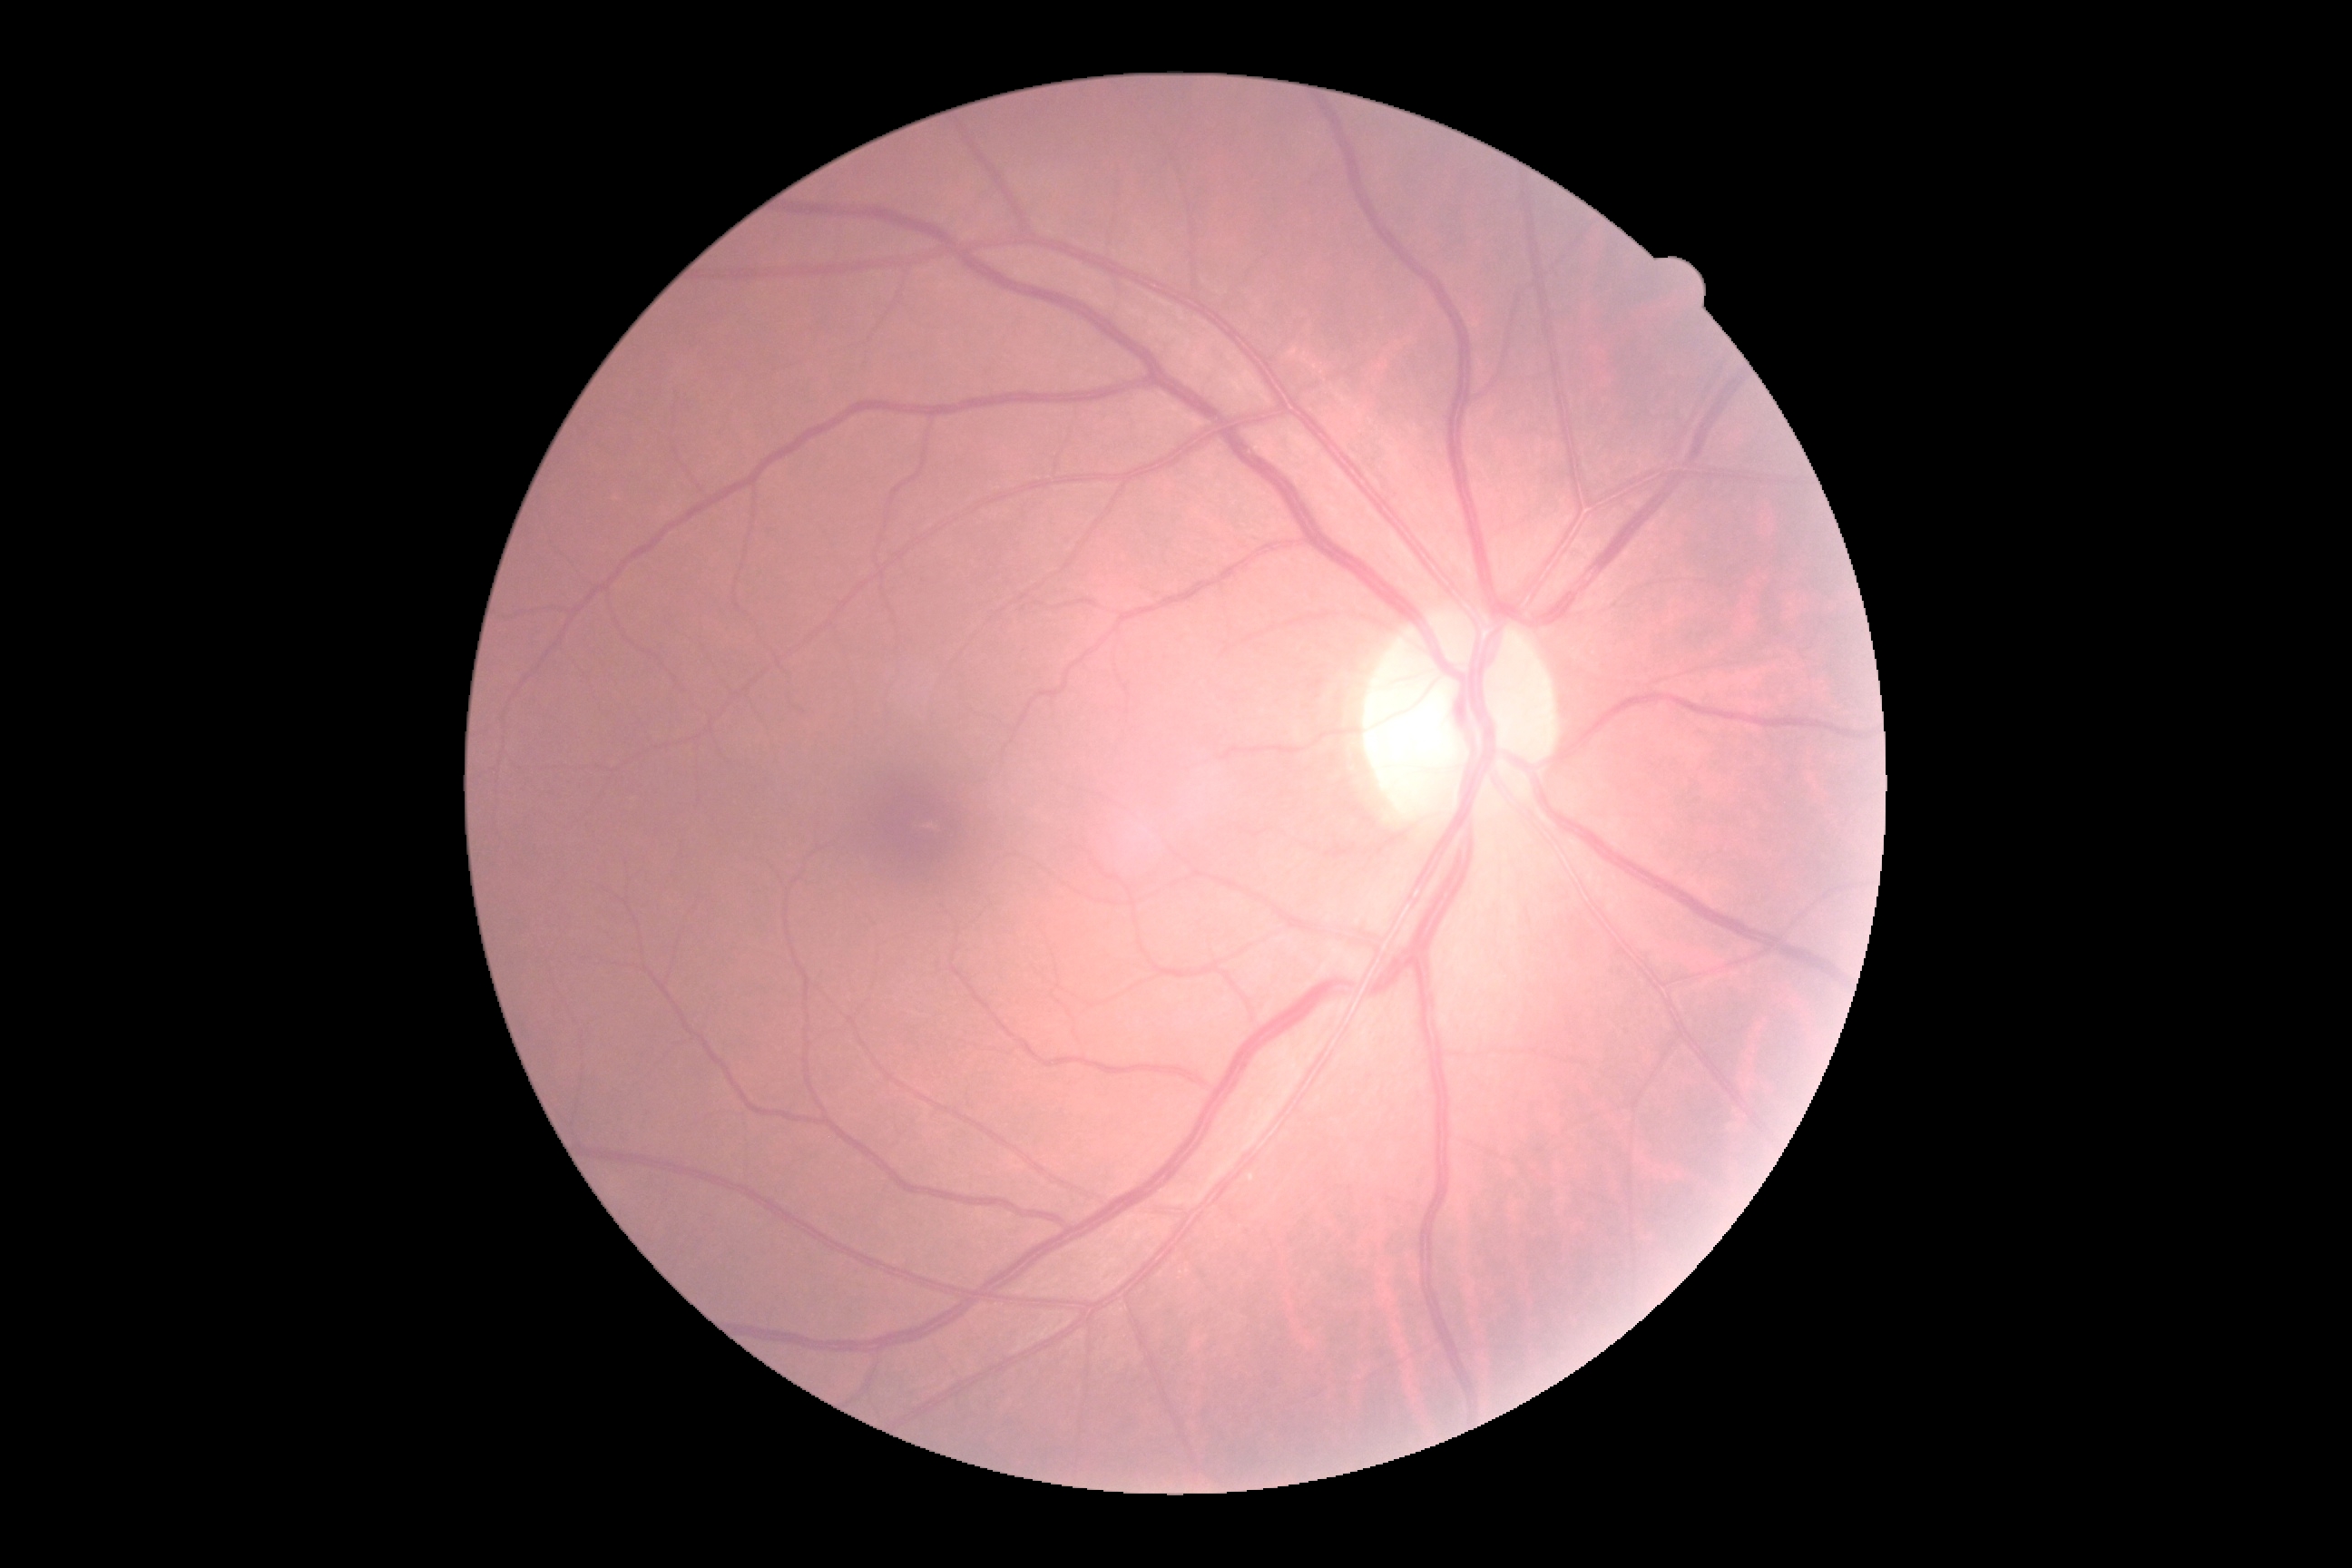 DR impression = no DR findings; diabetic retinopathy grade = 0.